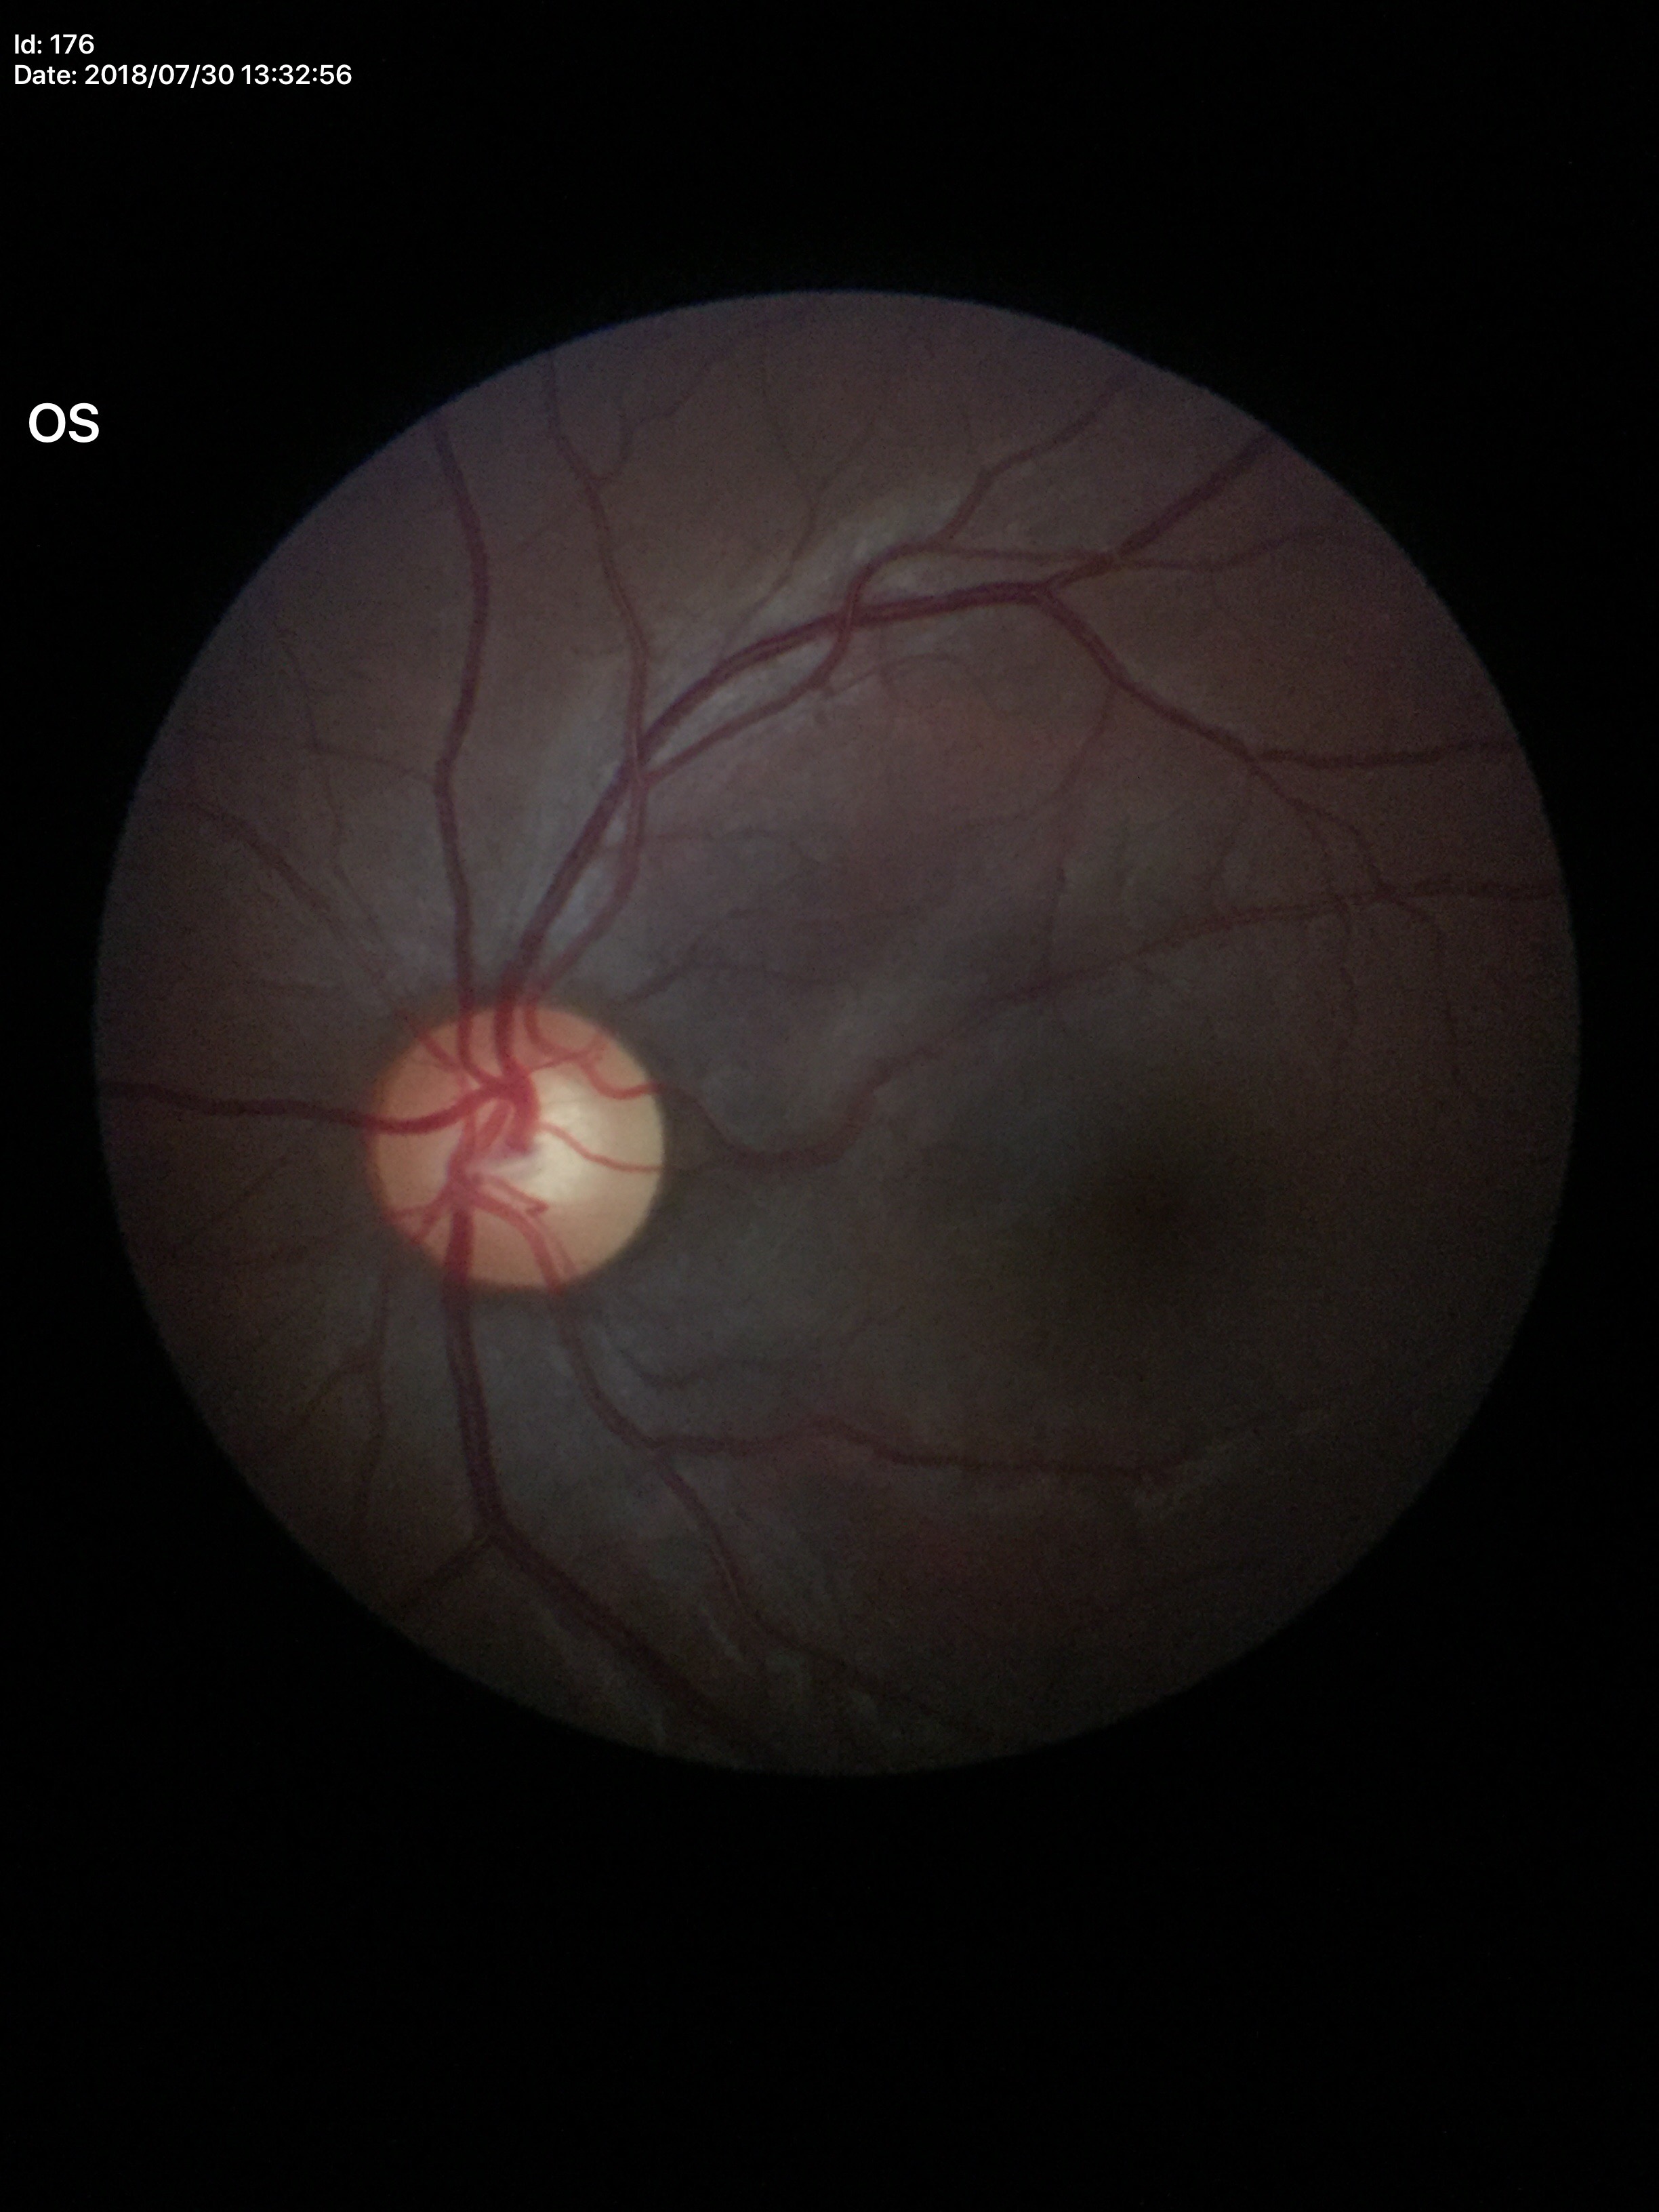
Optic disc analysis:
* Glaucoma impression — no suspicious findings
* vertical cup-disc ratio — 0.57
* horizontal cup-to-disc ratio — 0.59